Axial length (AL): 22.63 mm. 2212 x 1661 pixels. Optic disc at the center of the field. 69 years old. 30° FOV. Camera: Topcon TRC-NW400 — 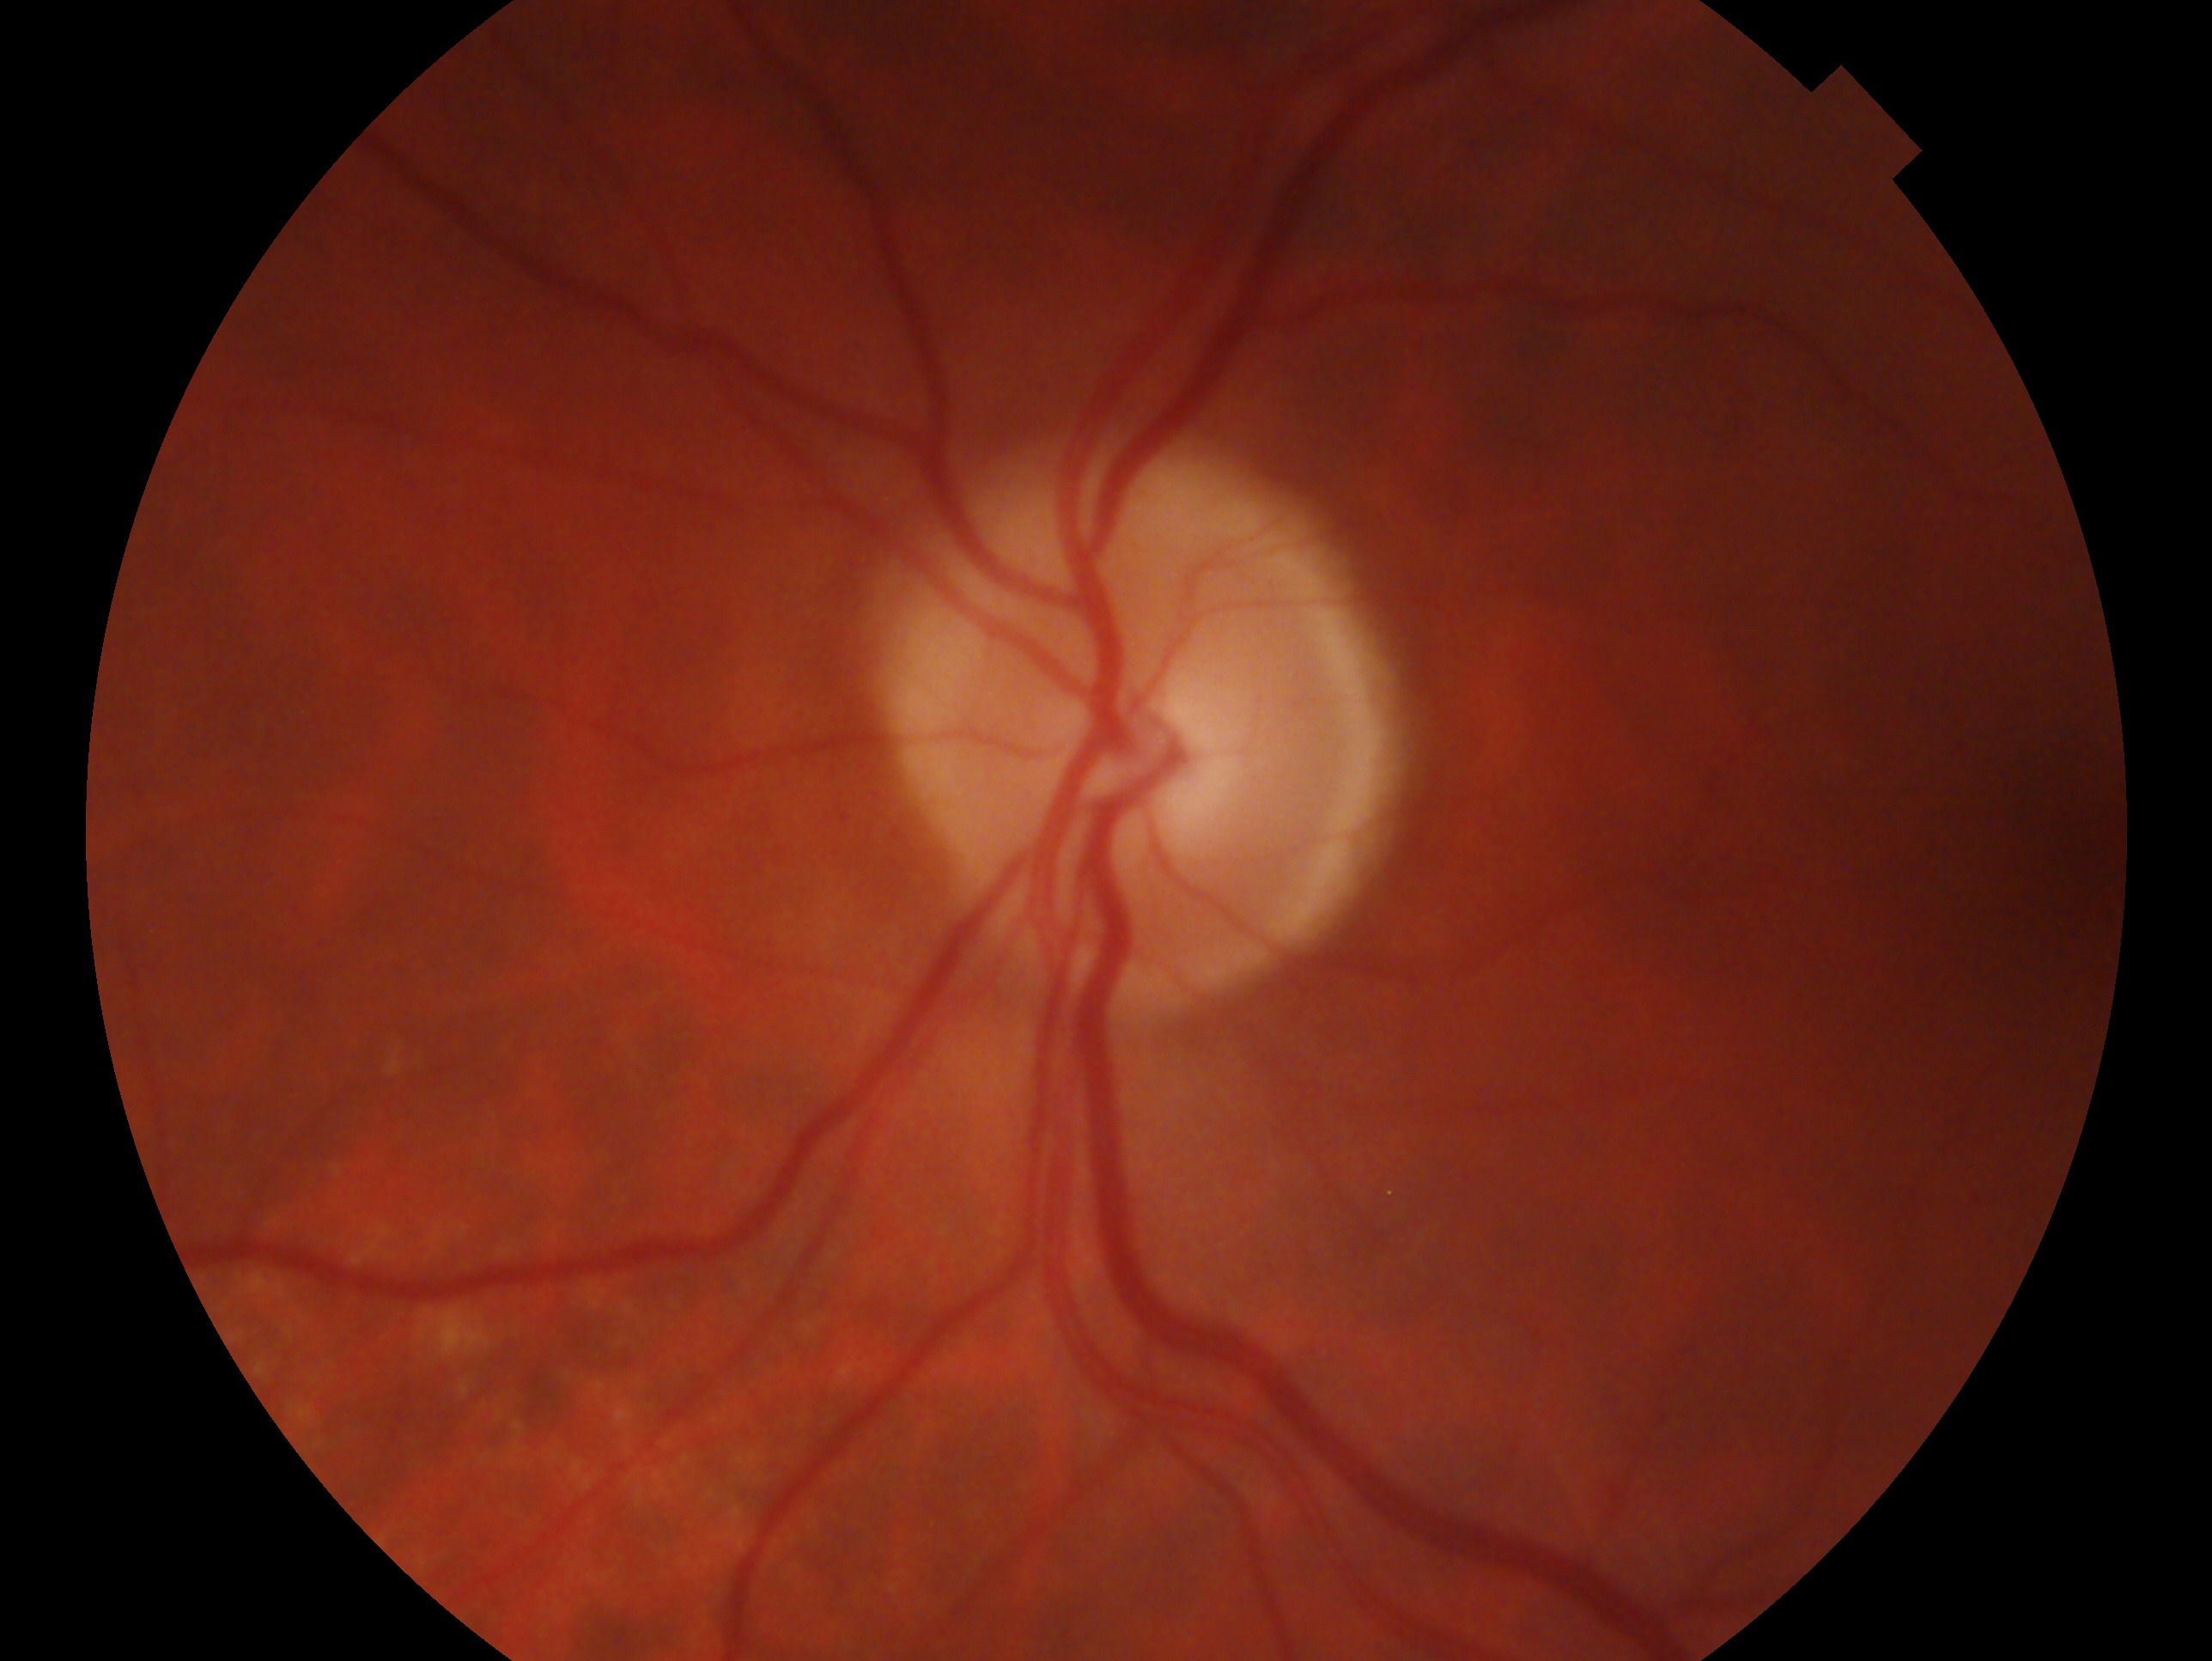

Glaucoma status — suspicious for glaucoma. Eye: left.